Color fundus photograph
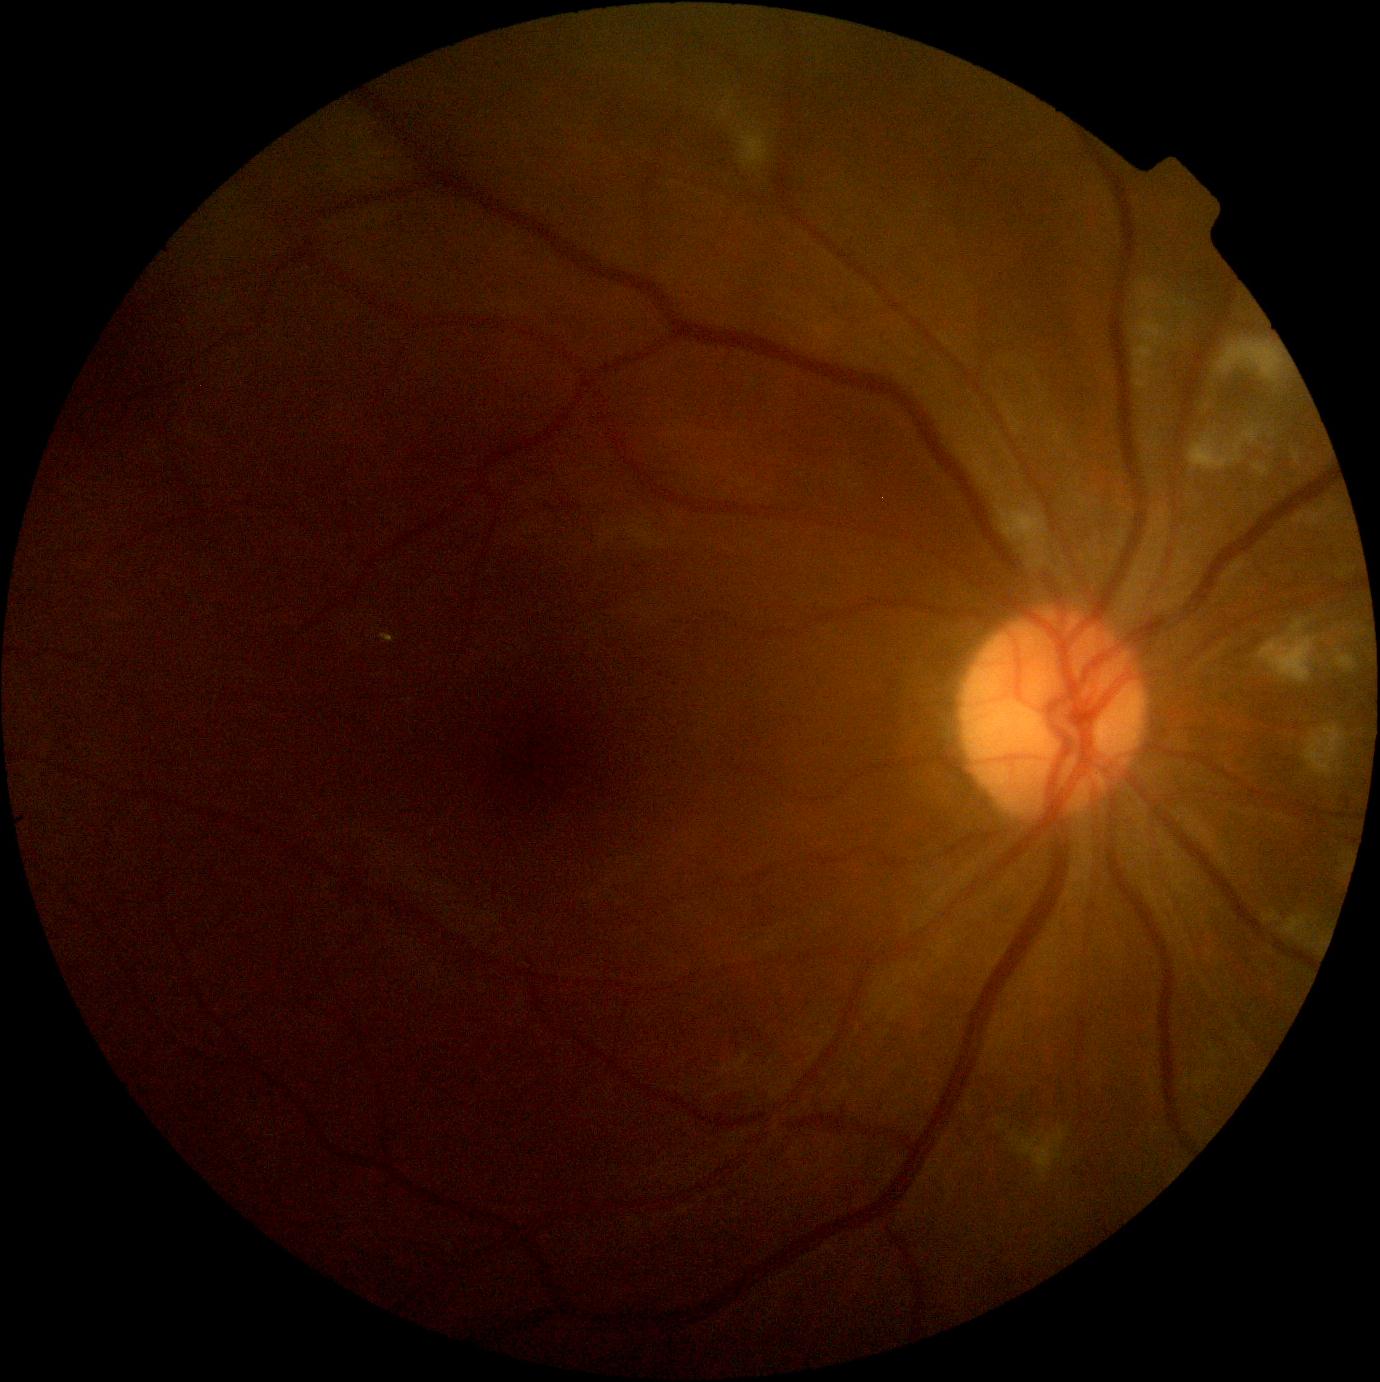

Diabetic retinopathy (DR) is grade 2.